1932 by 1932 pixels
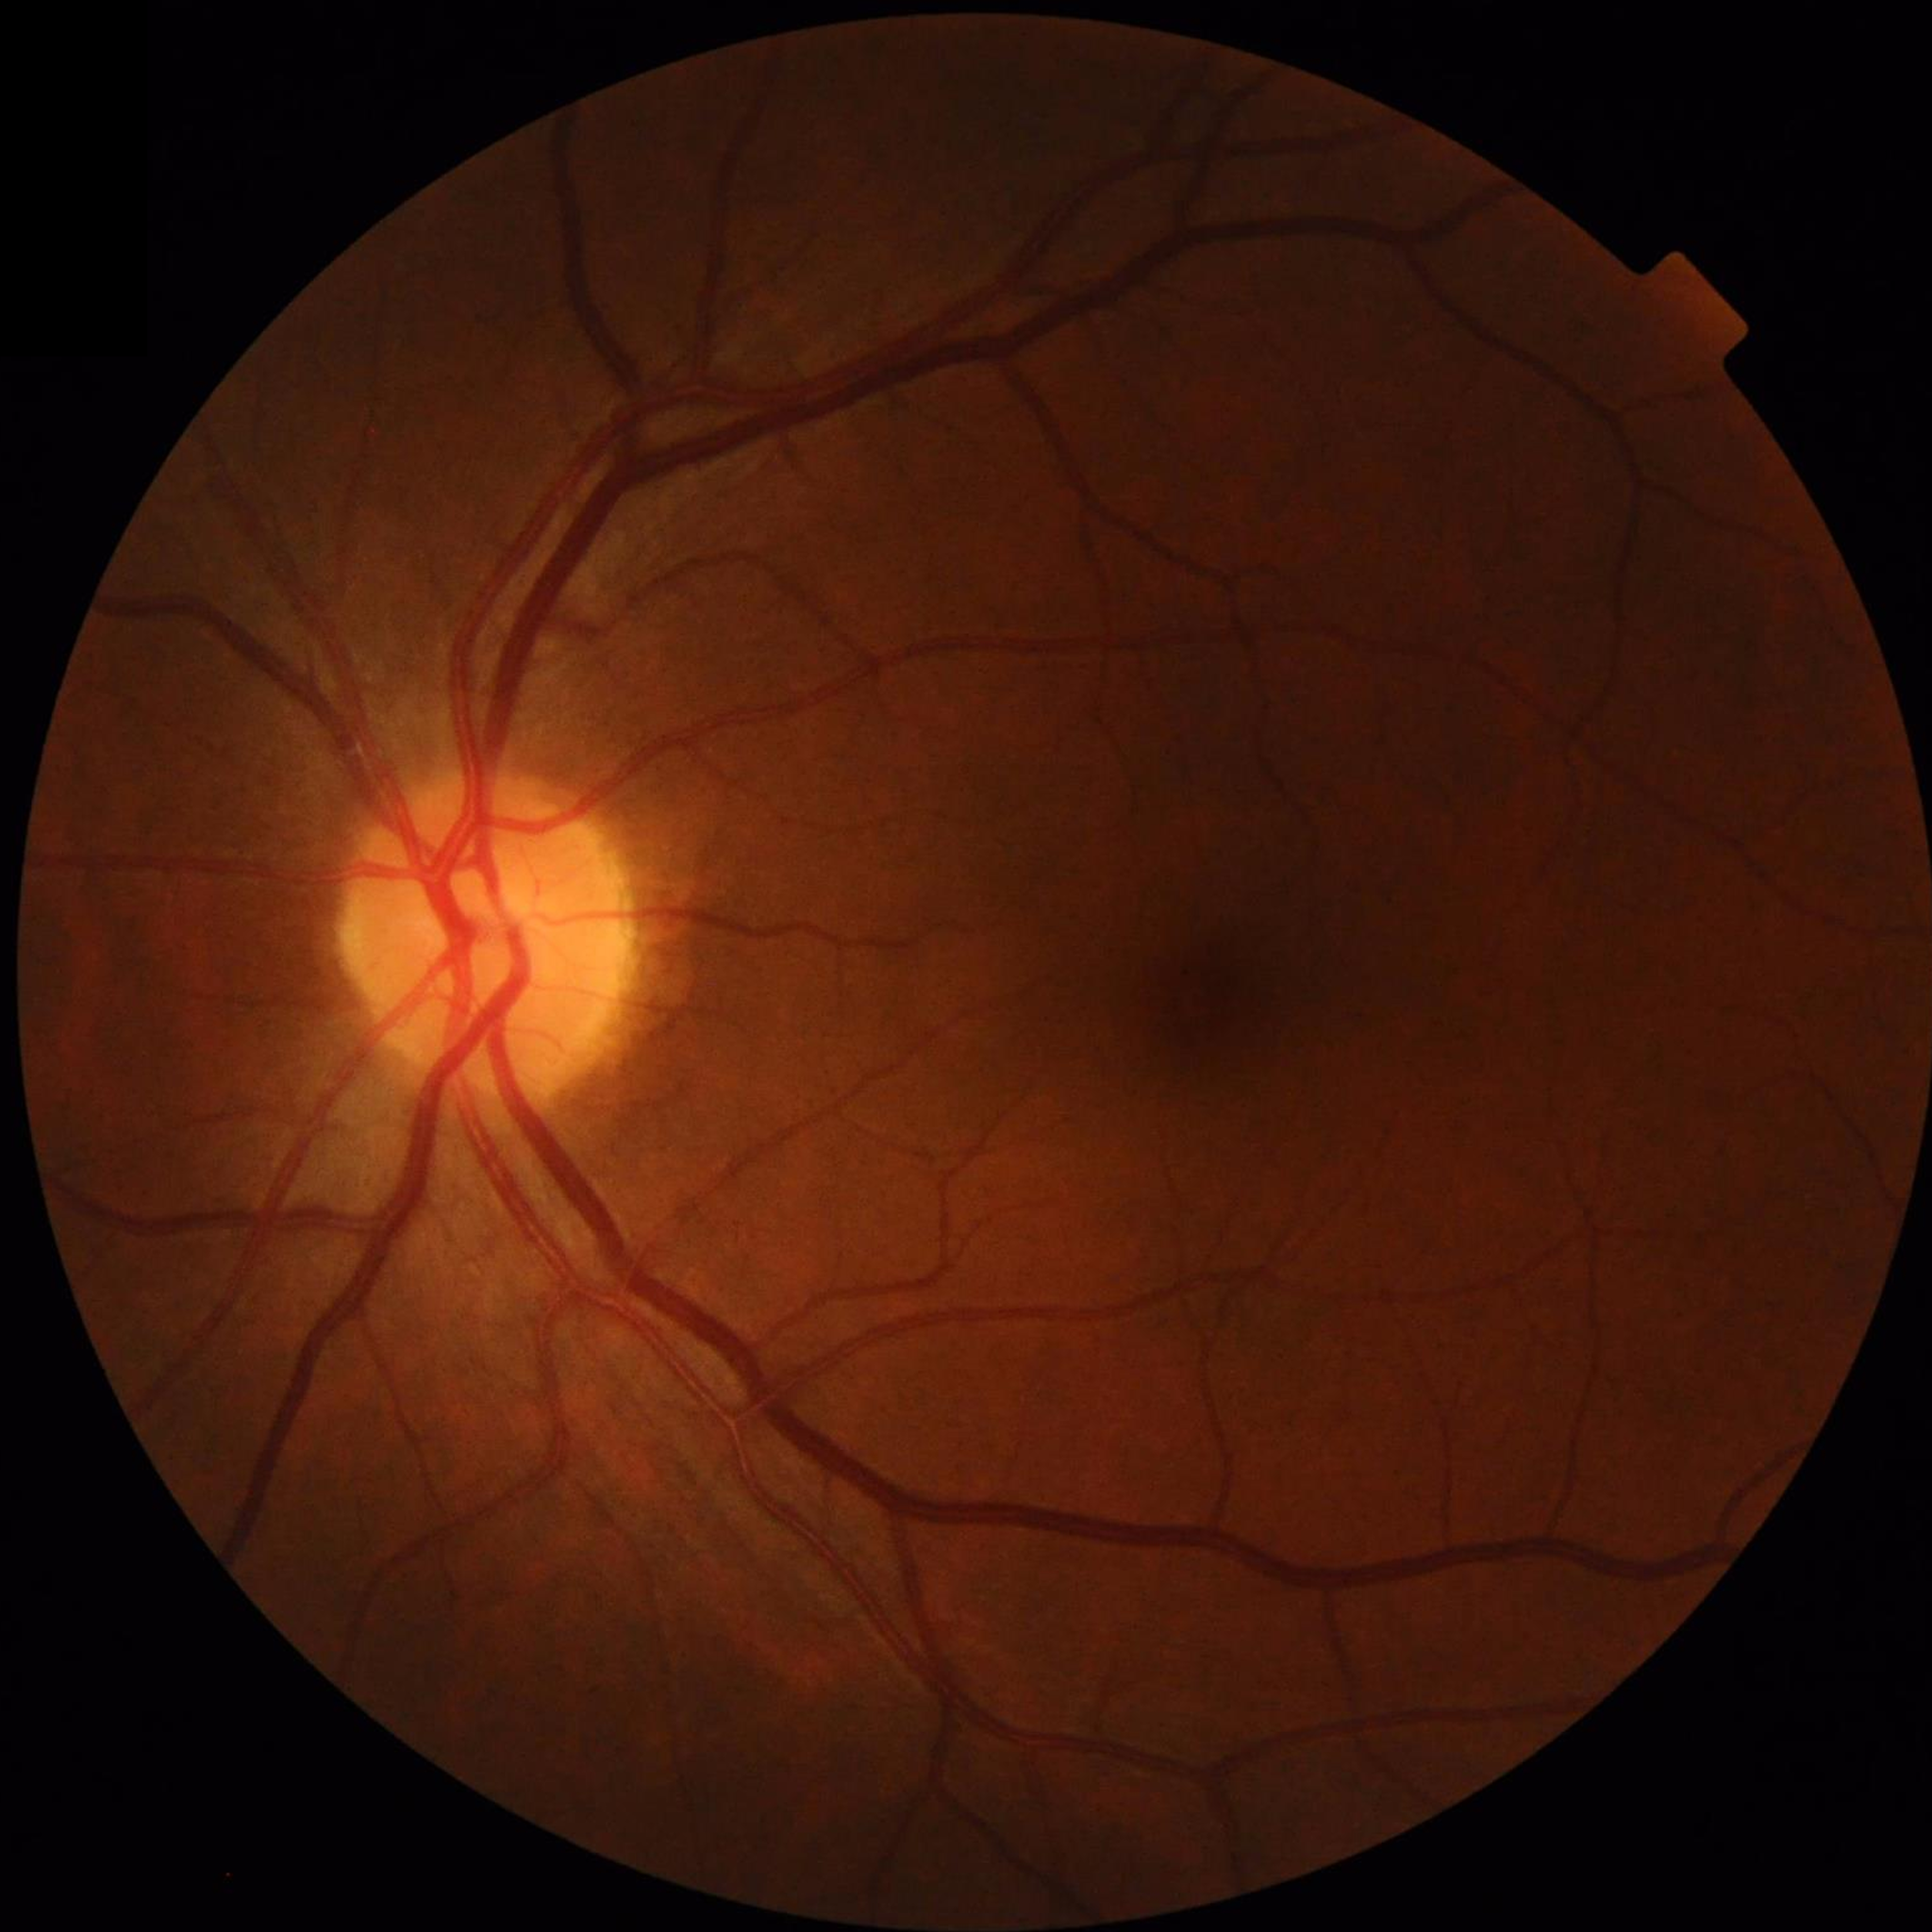

Automated quality assessment = no quality issues identified; Condition = no AMD, diabetic retinopathy, or glaucoma.